Color fundus photograph — 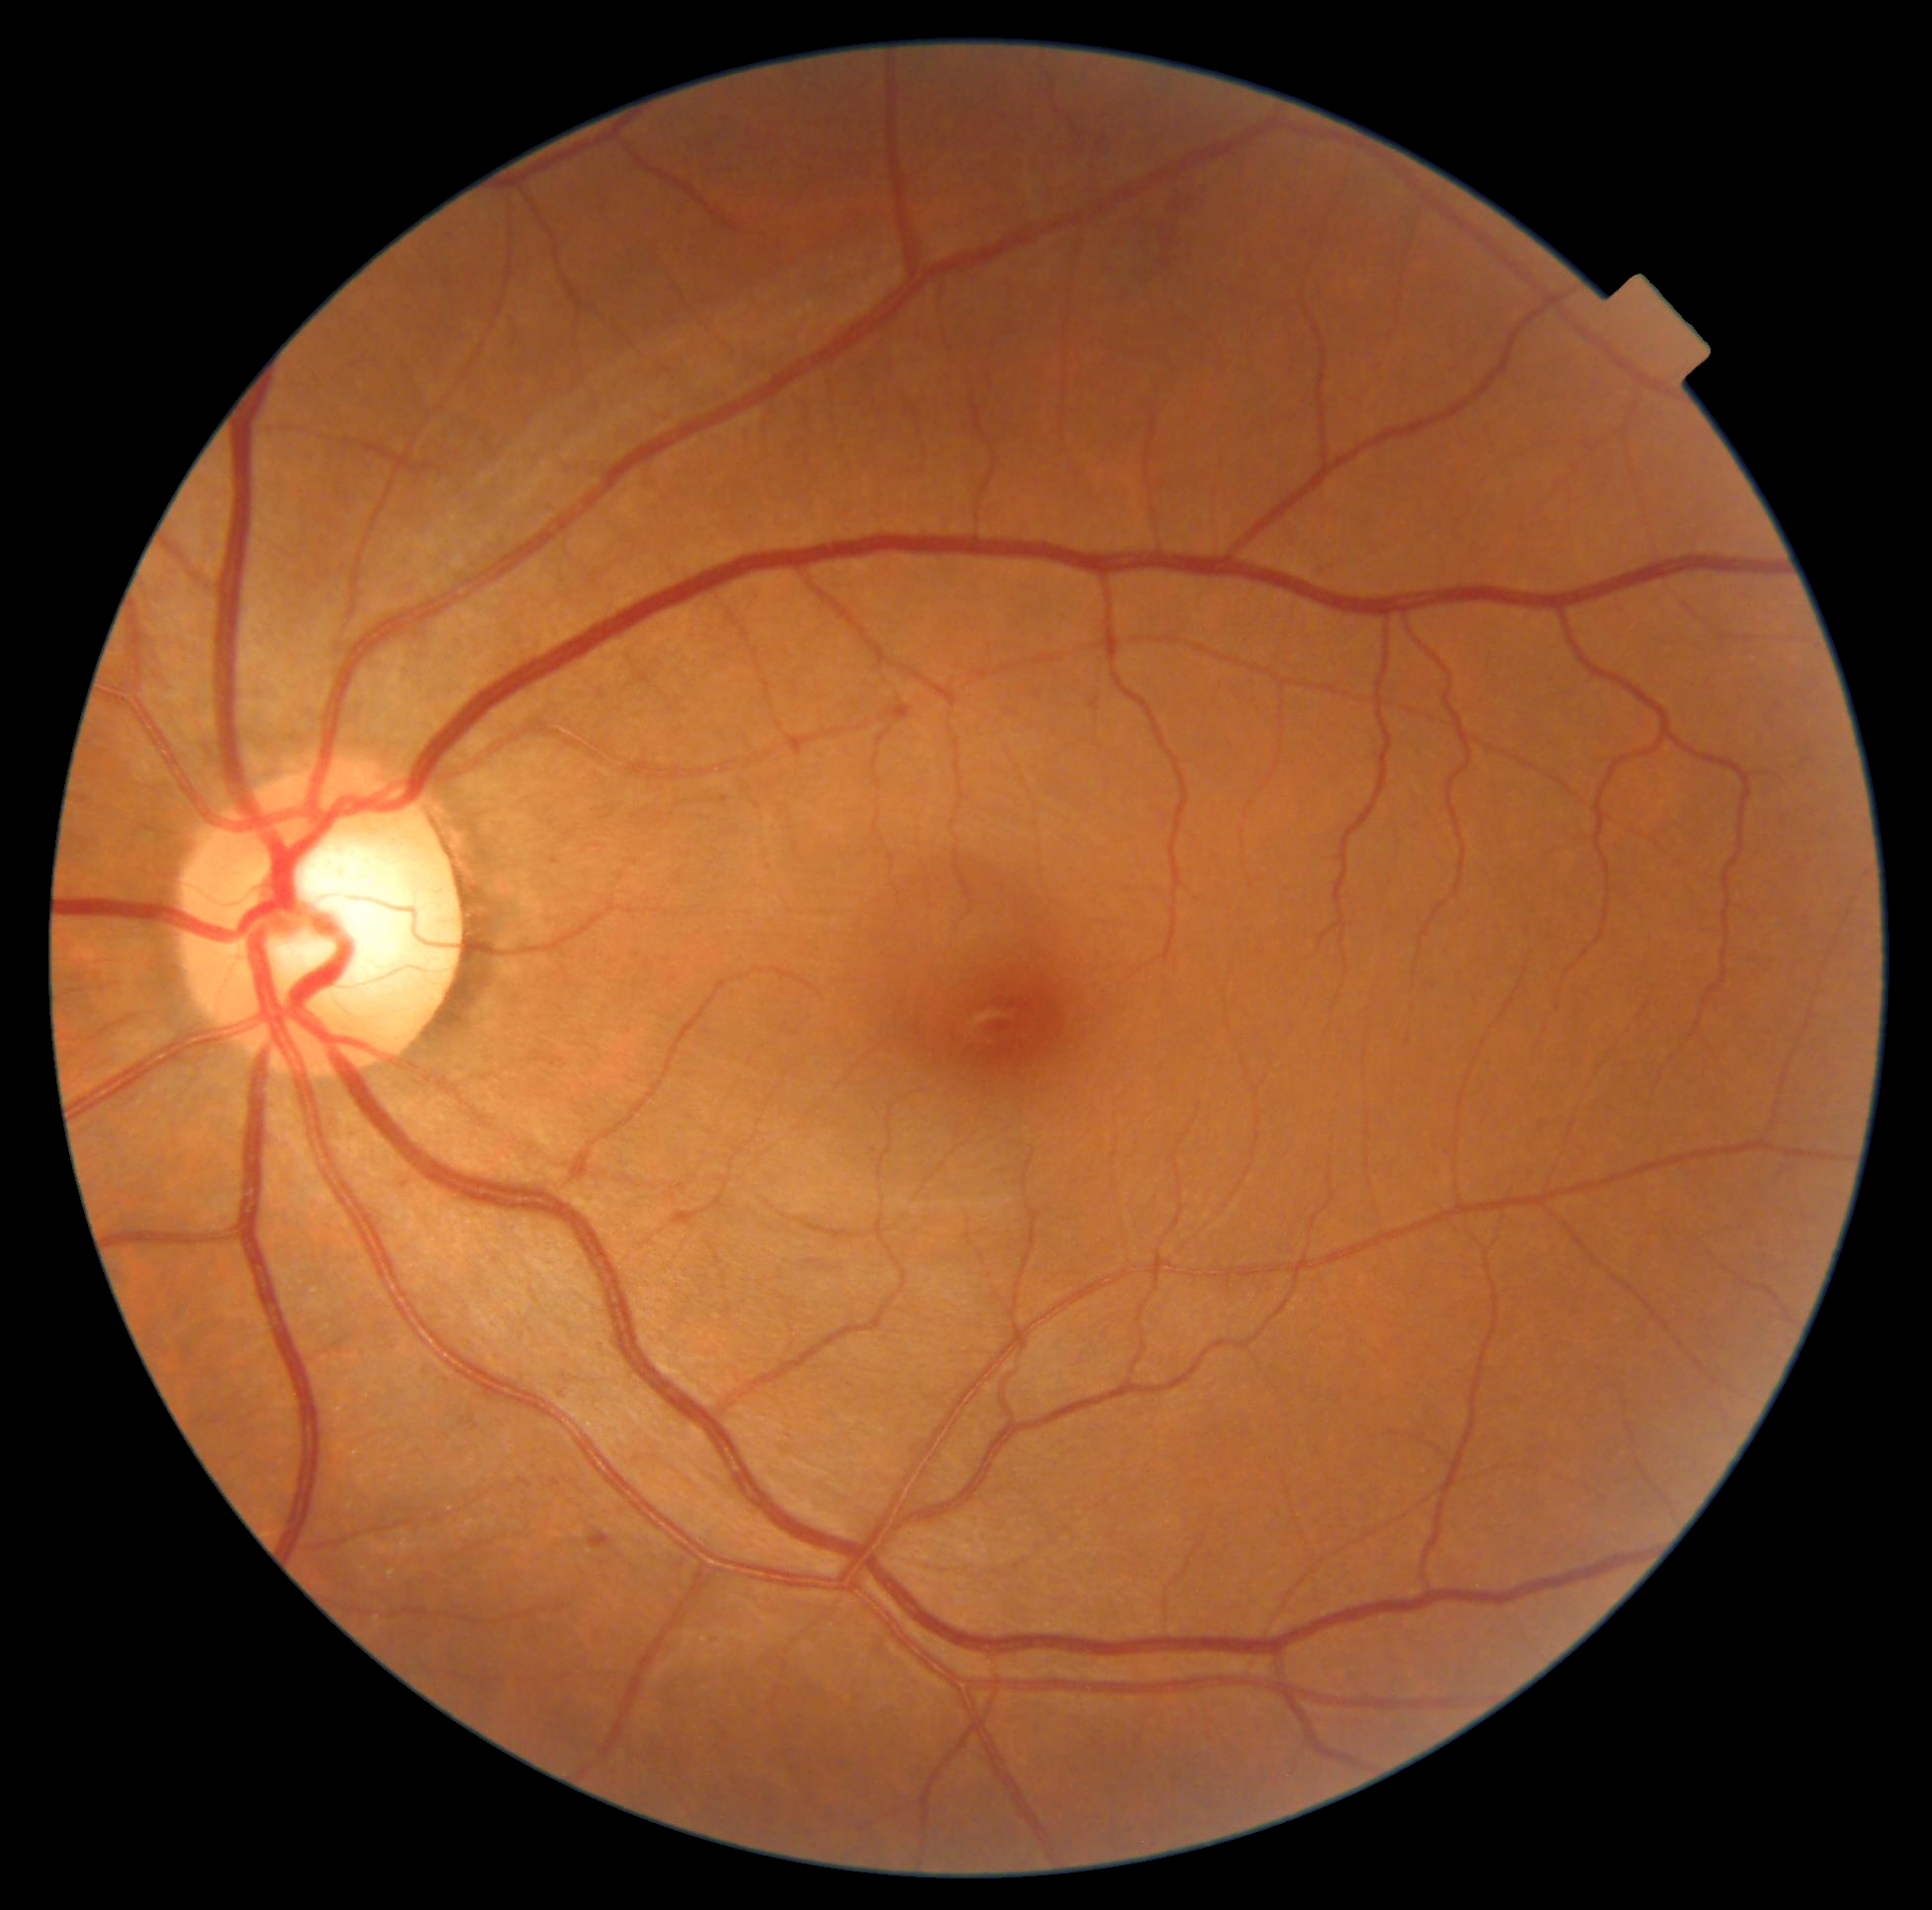

Findings:
* diabetic retinopathy severity: grade 2 (moderate NPDR)